1932x1910; 45-degree field of view:
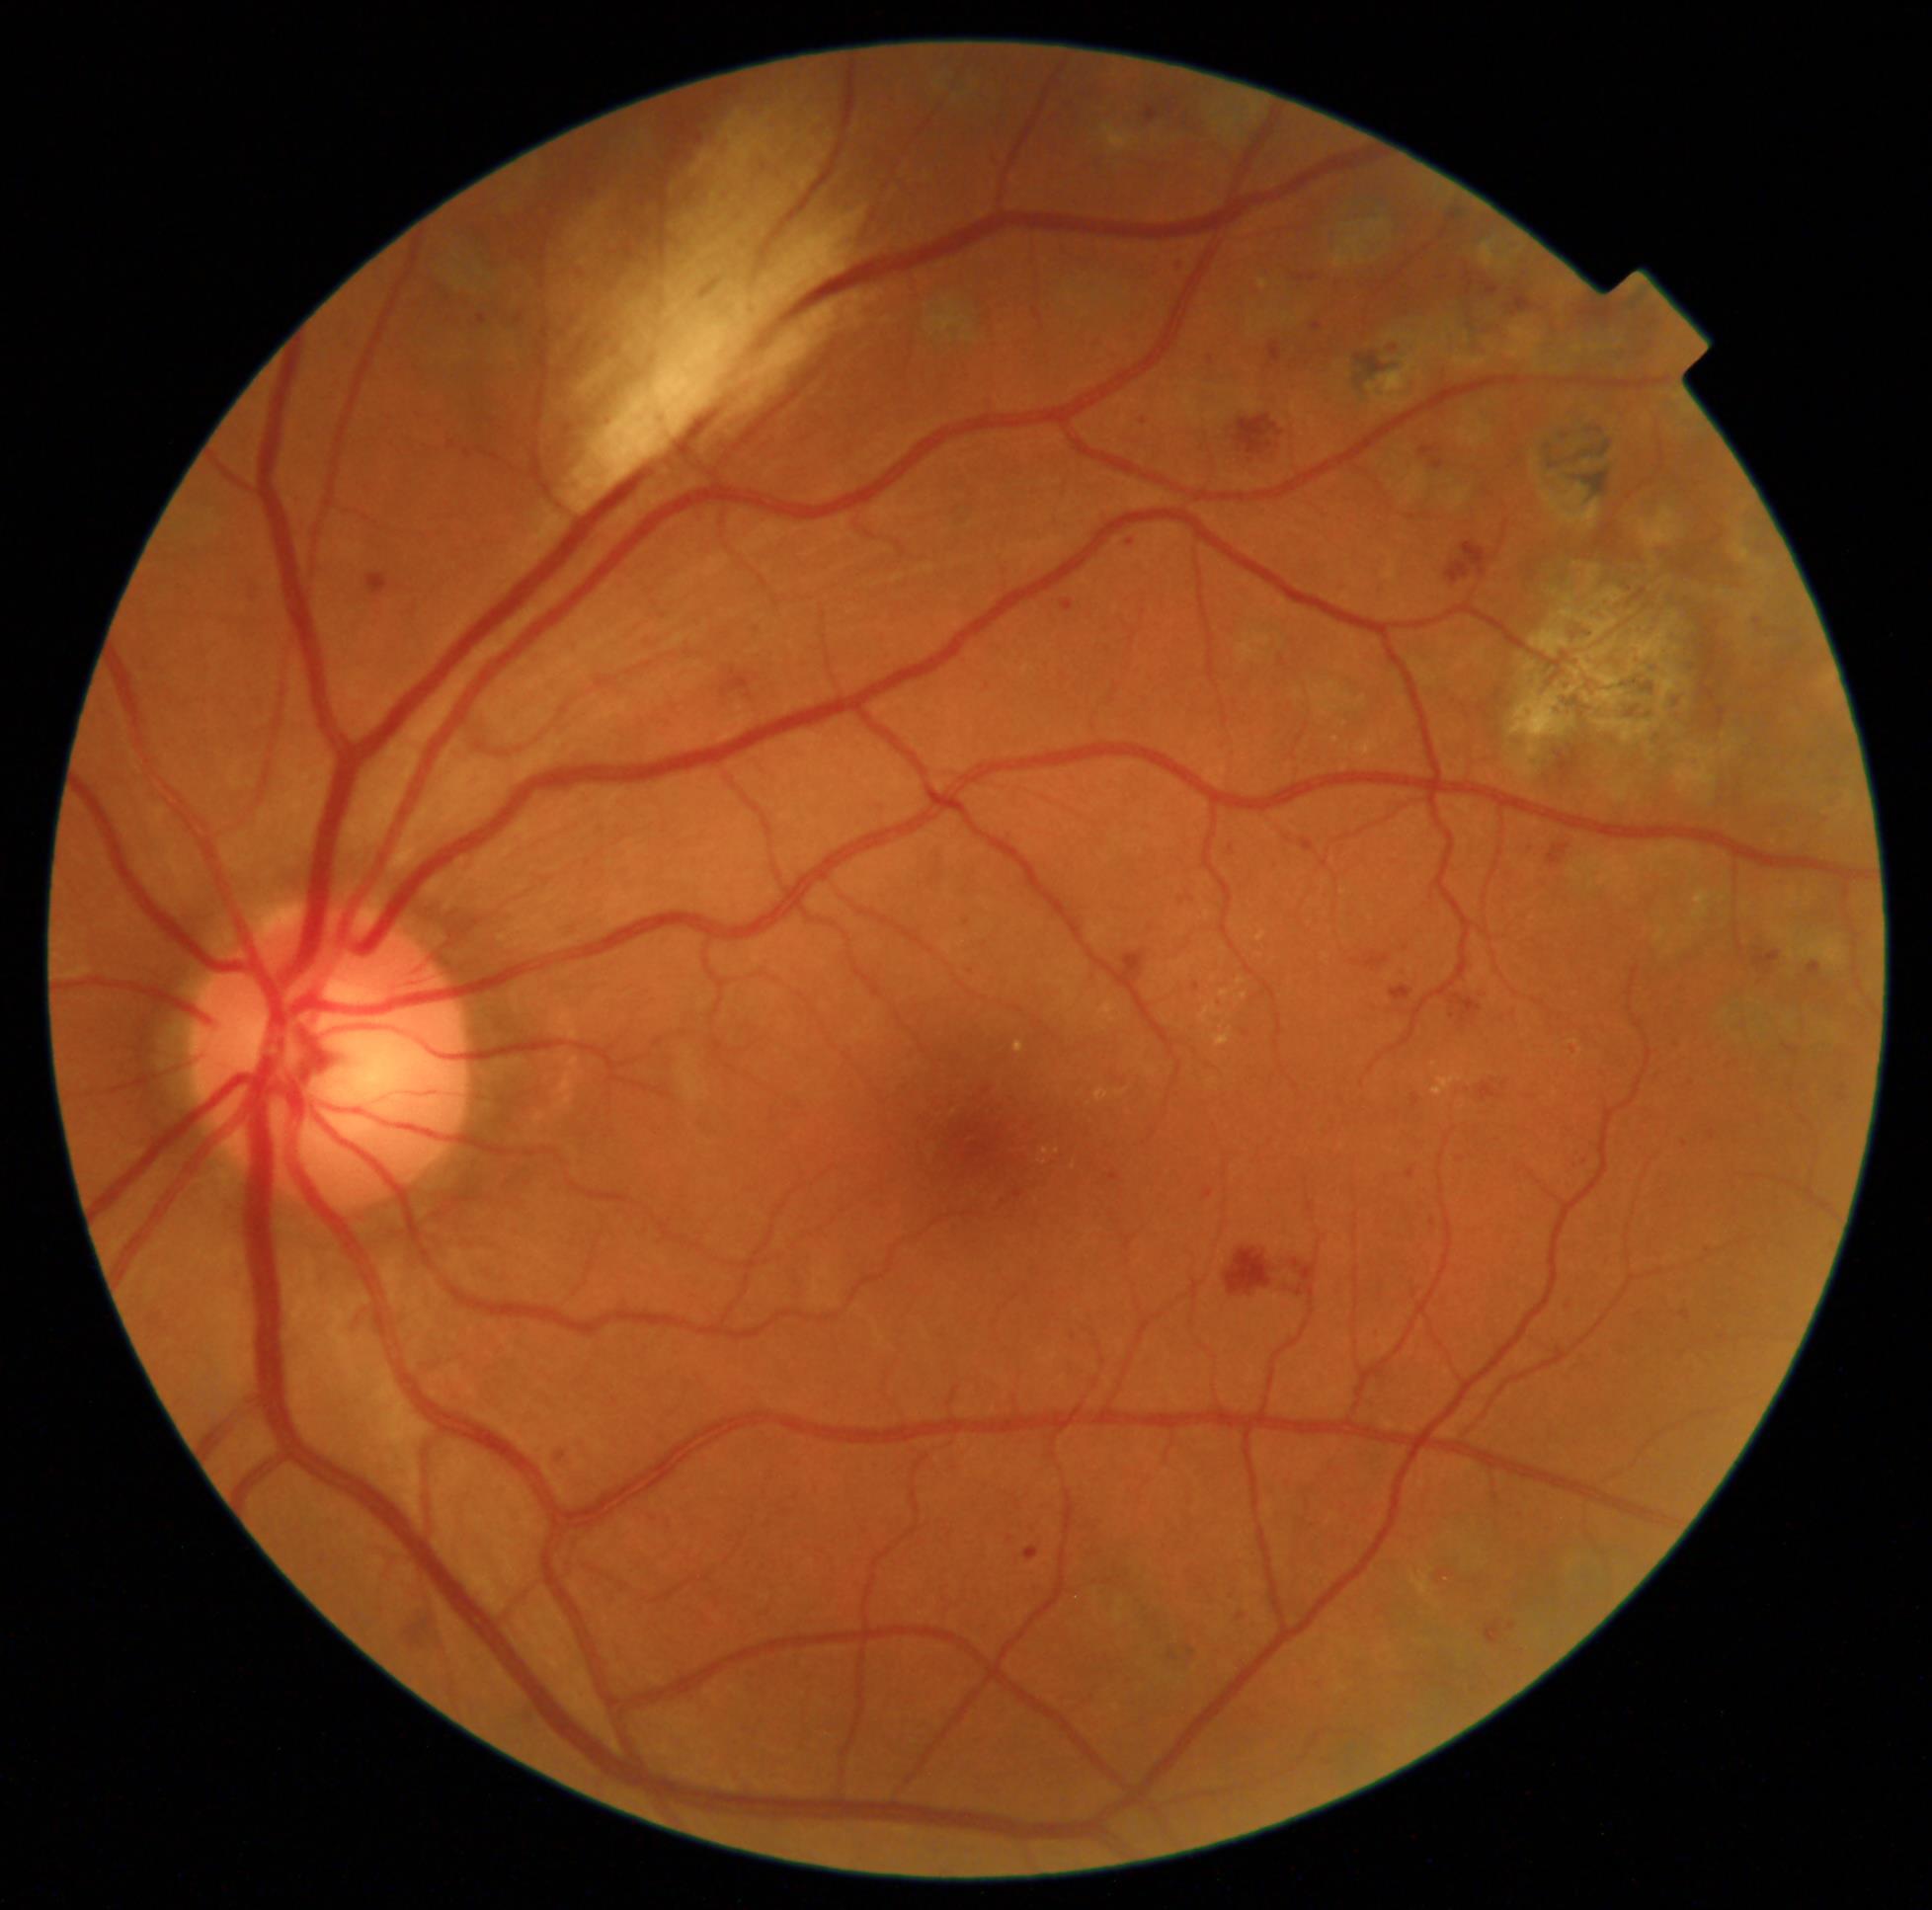
diabetic retinopathy (DR)@2.